Natus RetCam Envision, 130° FOV. Infant wide-field fundus photograph
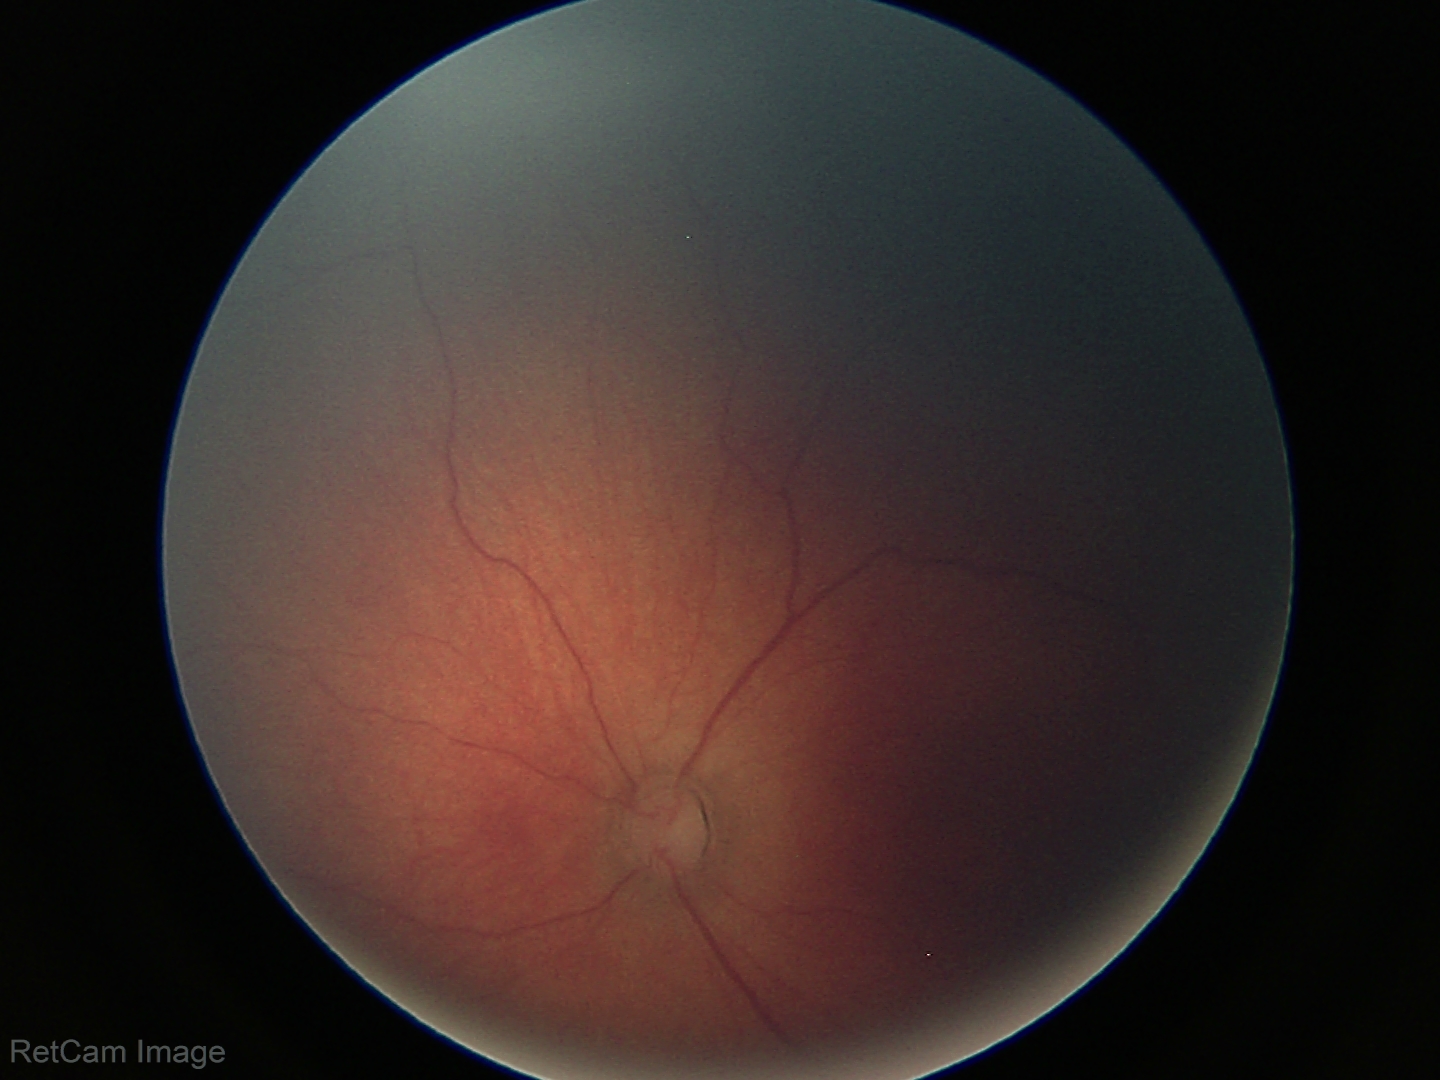 Q: What is the screening diagnosis?
A: ROP stage 2
Q: Plus disease status?
A: no plus disease